640x480; pediatric wide-field fundus photograph
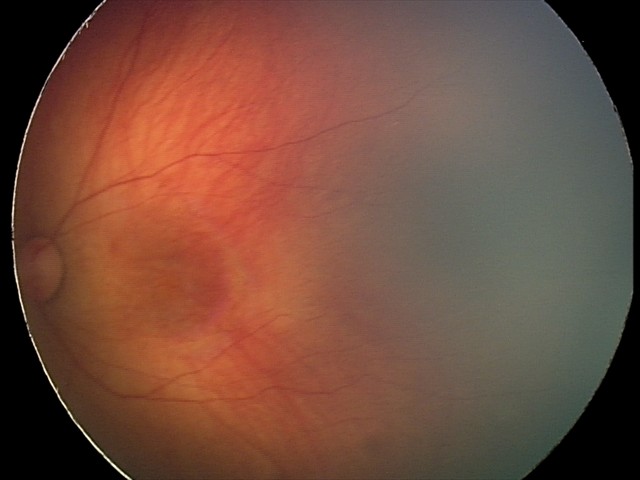

Screening series with retinal hemorrhages.